1659x2212.
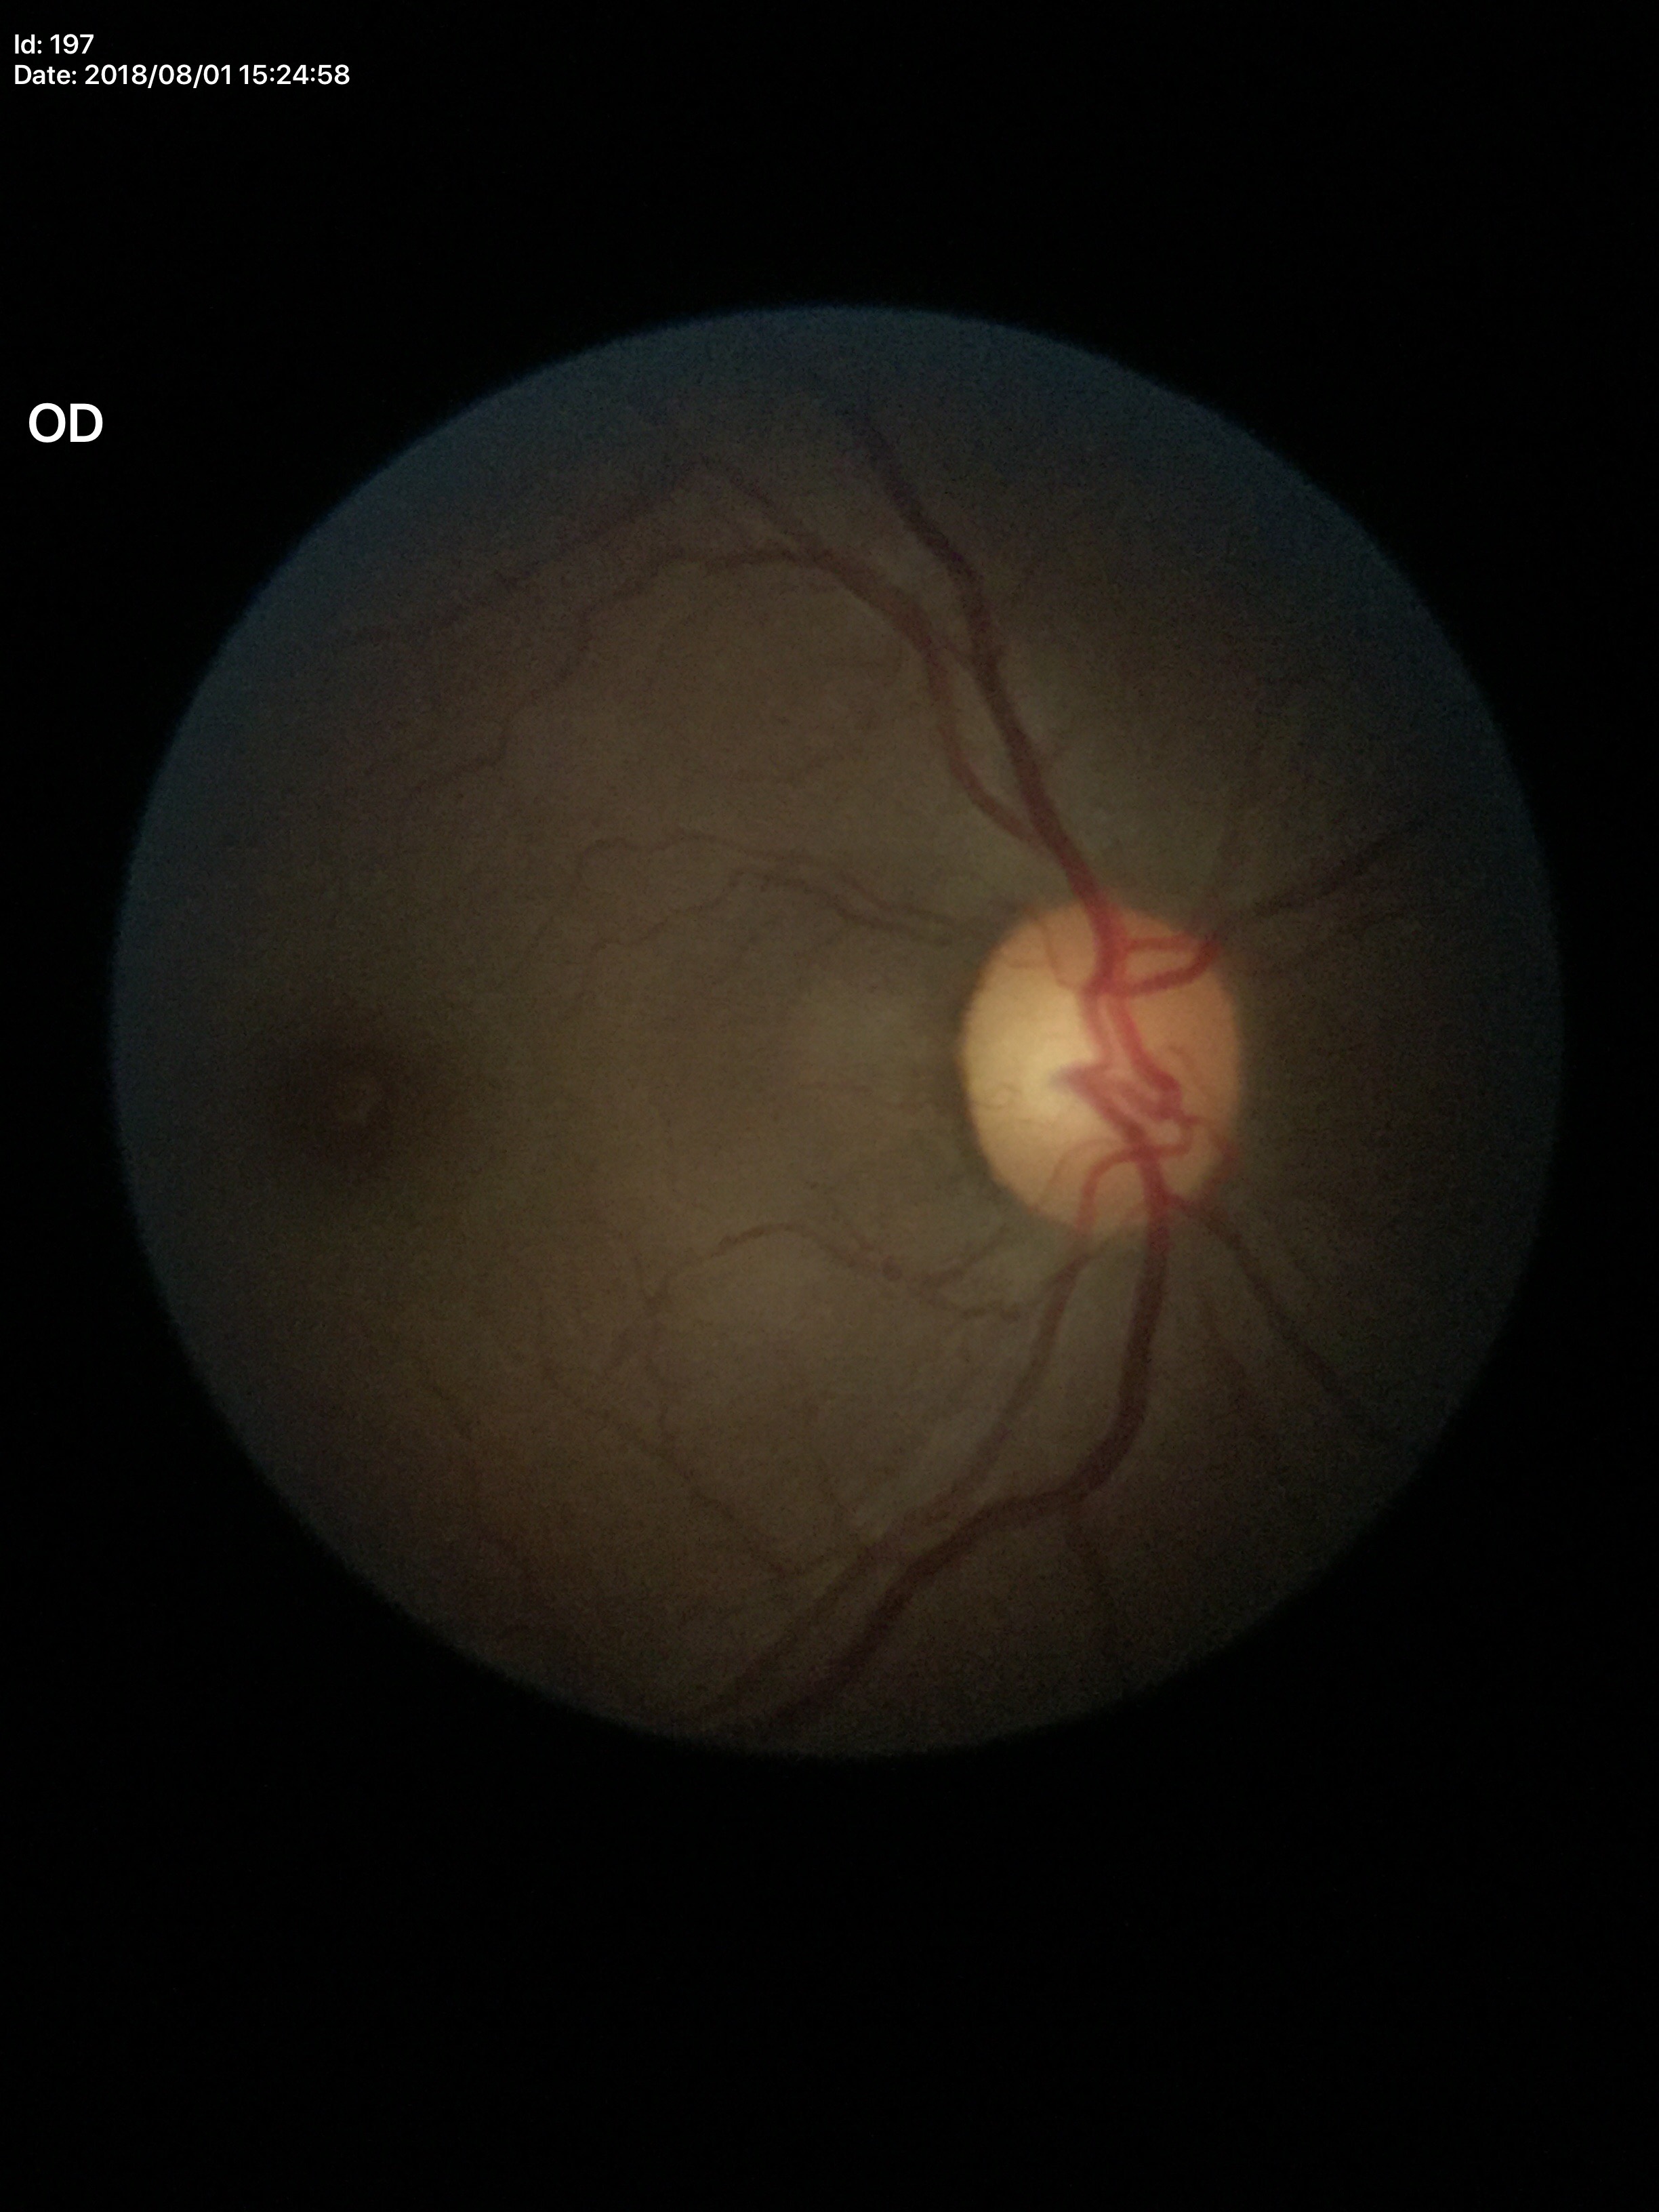
Glaucoma screening impression: no suspicious findings. Horizontal C/D ratio is 0.59. Vertical CDR of 0.57.